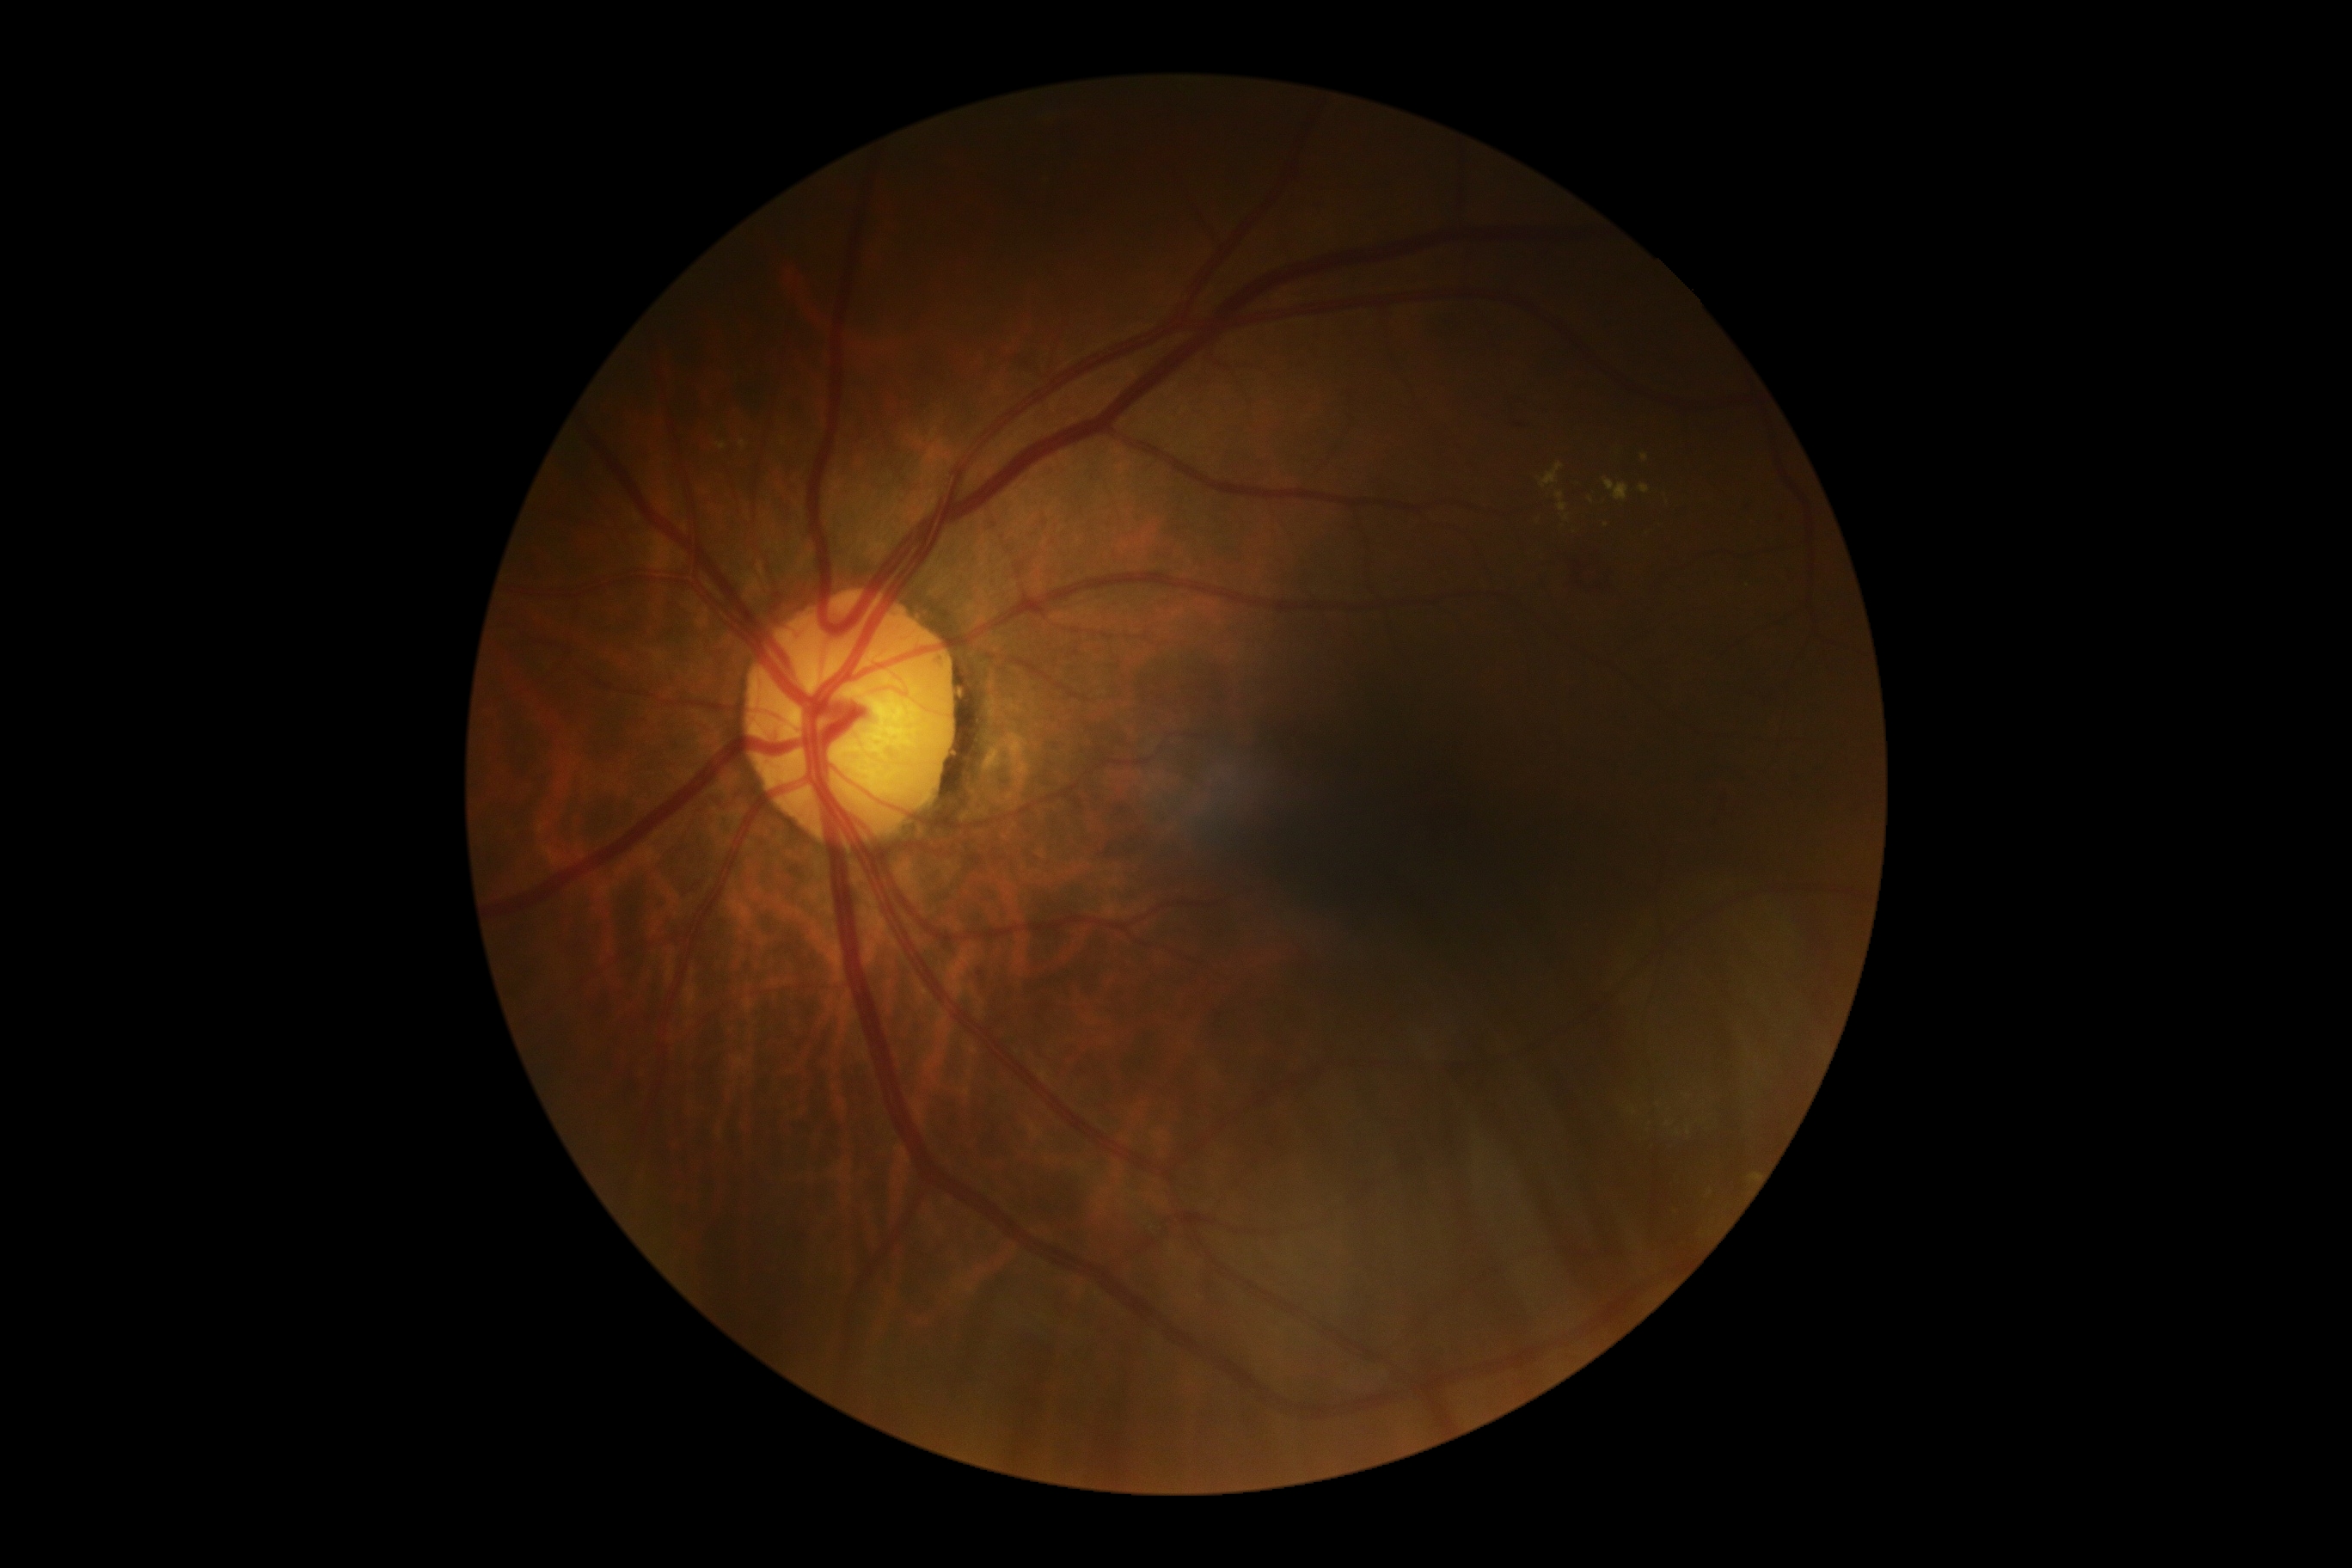
dr_grade: 2